Fundus photo. Image size 2212x1661. 30° field of view. Camera: Topcon TRC-NW400: 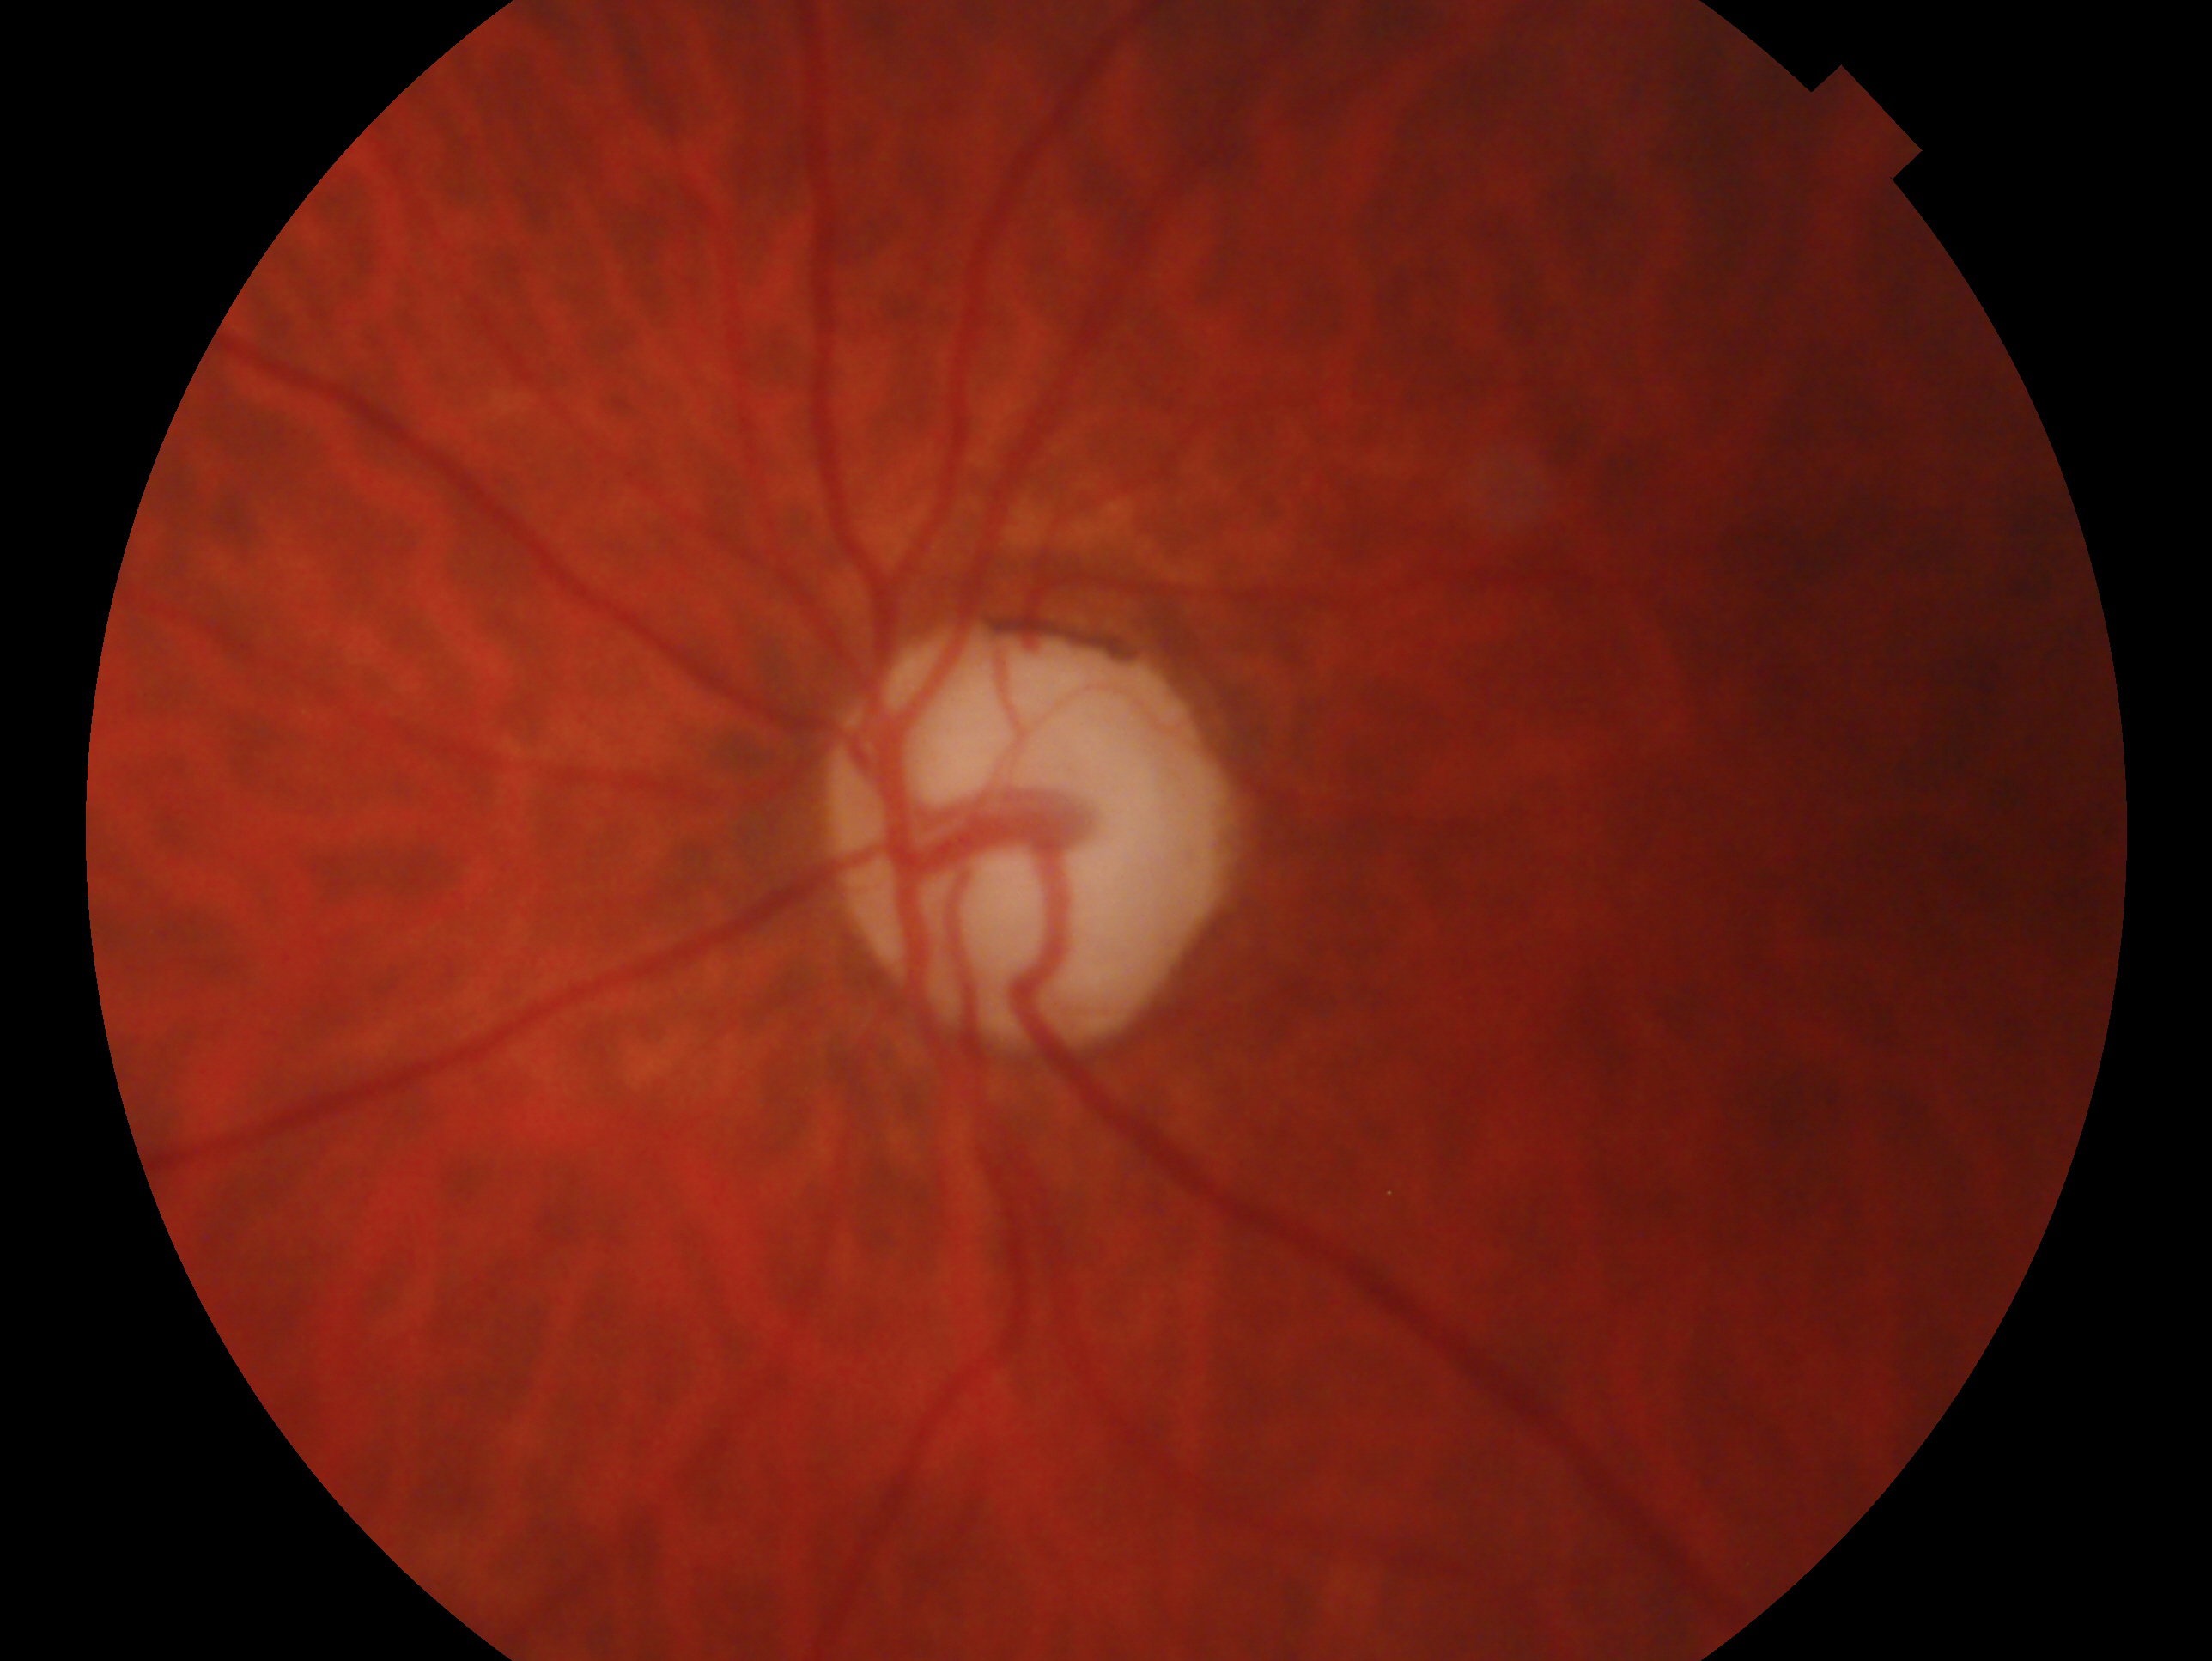
Imaged eye: left eye. Clinical classification: glaucomatous optic neuropathy — clinically confirmed glaucoma with characteristic optic nerve damage.